Fundus photo; without pupil dilation; acquired with a NIDEK AFC-230 — 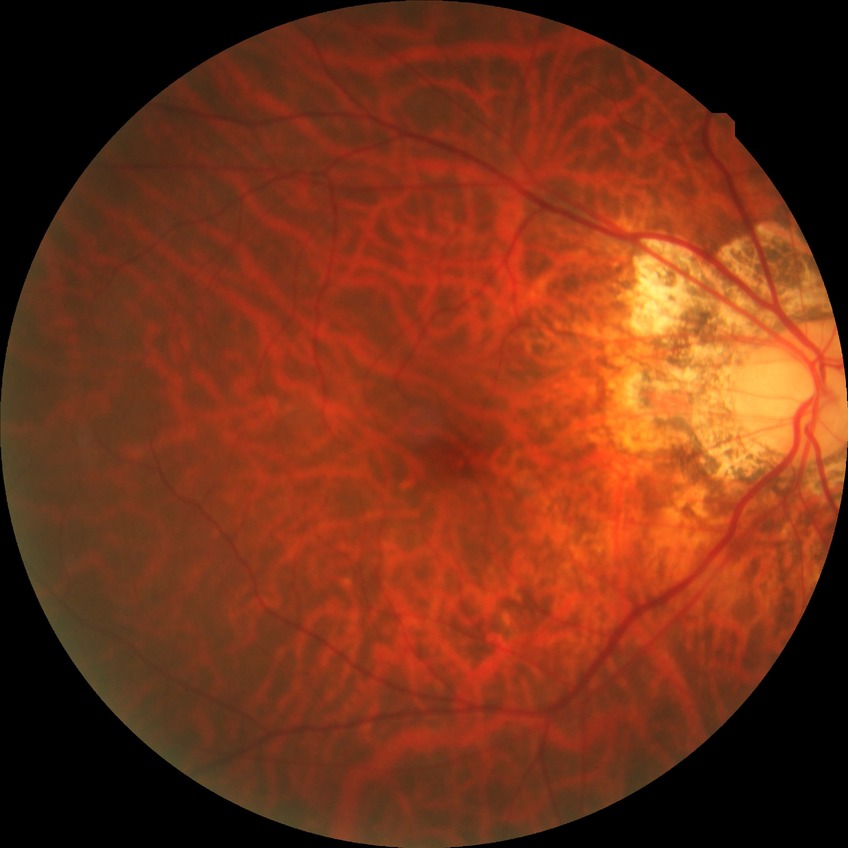
Findings:
• Davis DR grade: NDR